45° field of view, 1932x1916, color fundus image — 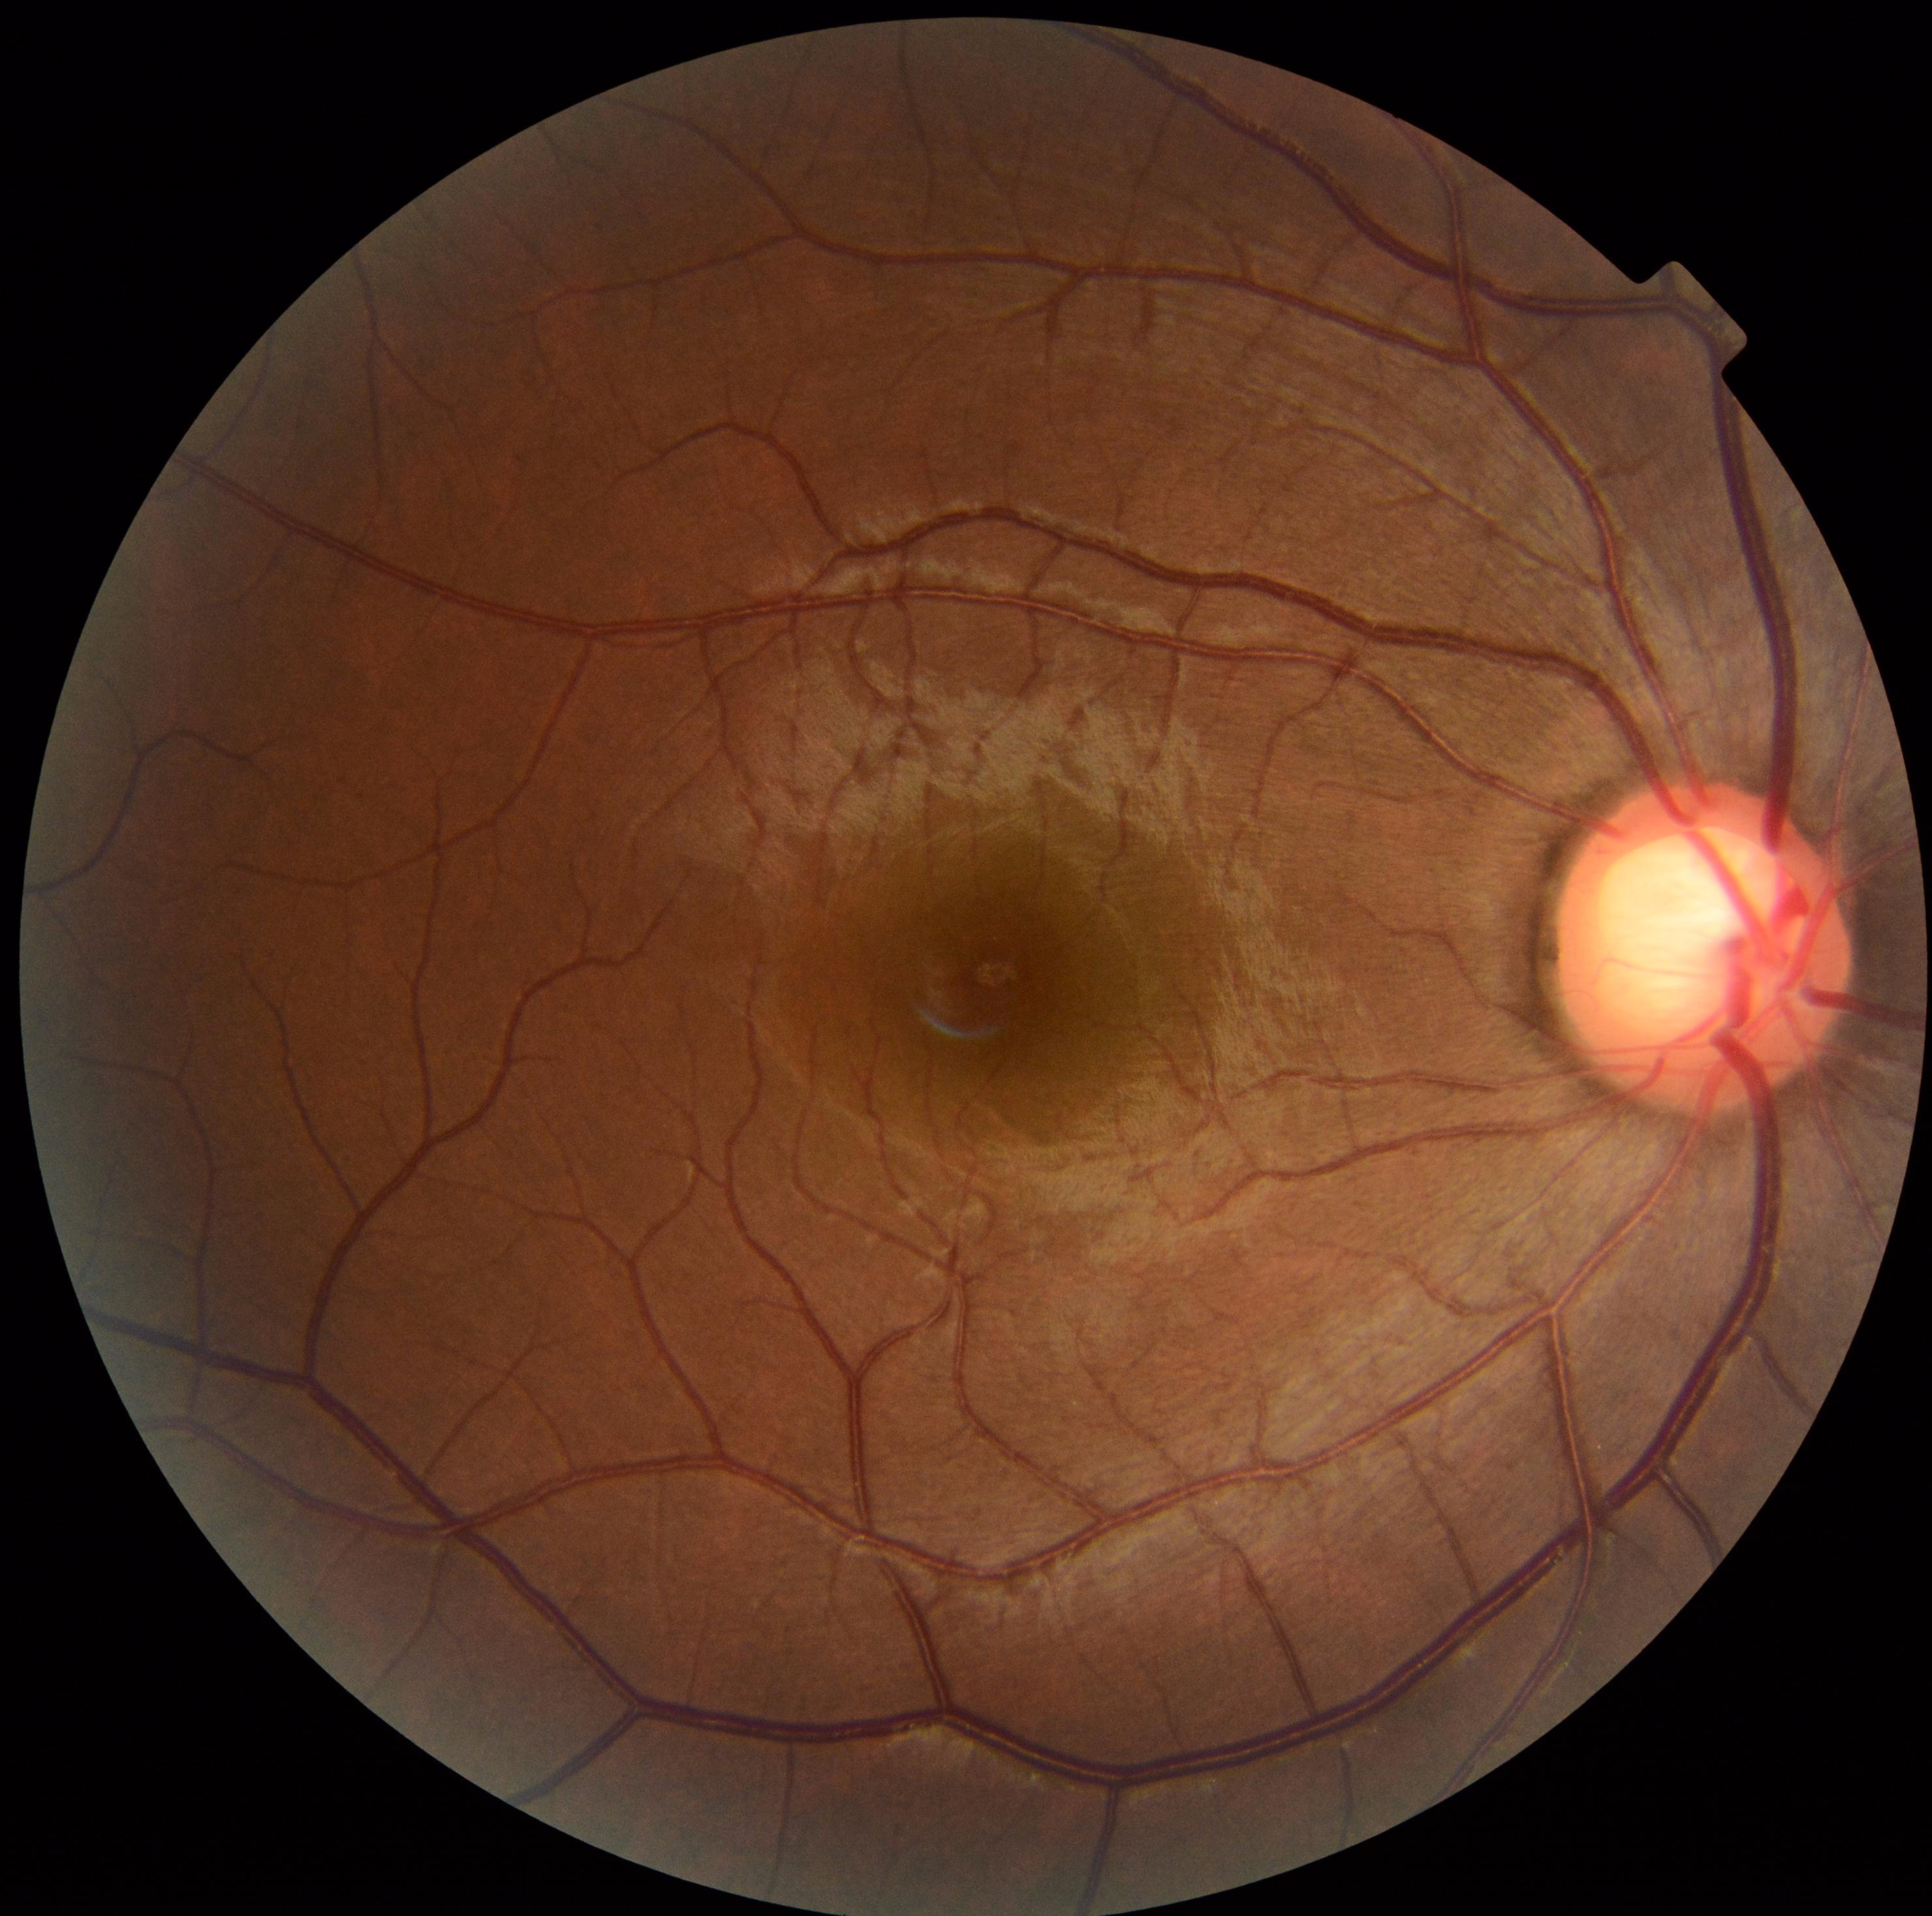
DR impression: no DR findings, diabetic retinopathy: grade 0 (no apparent retinopathy) — no visible signs of diabetic retinopathy.